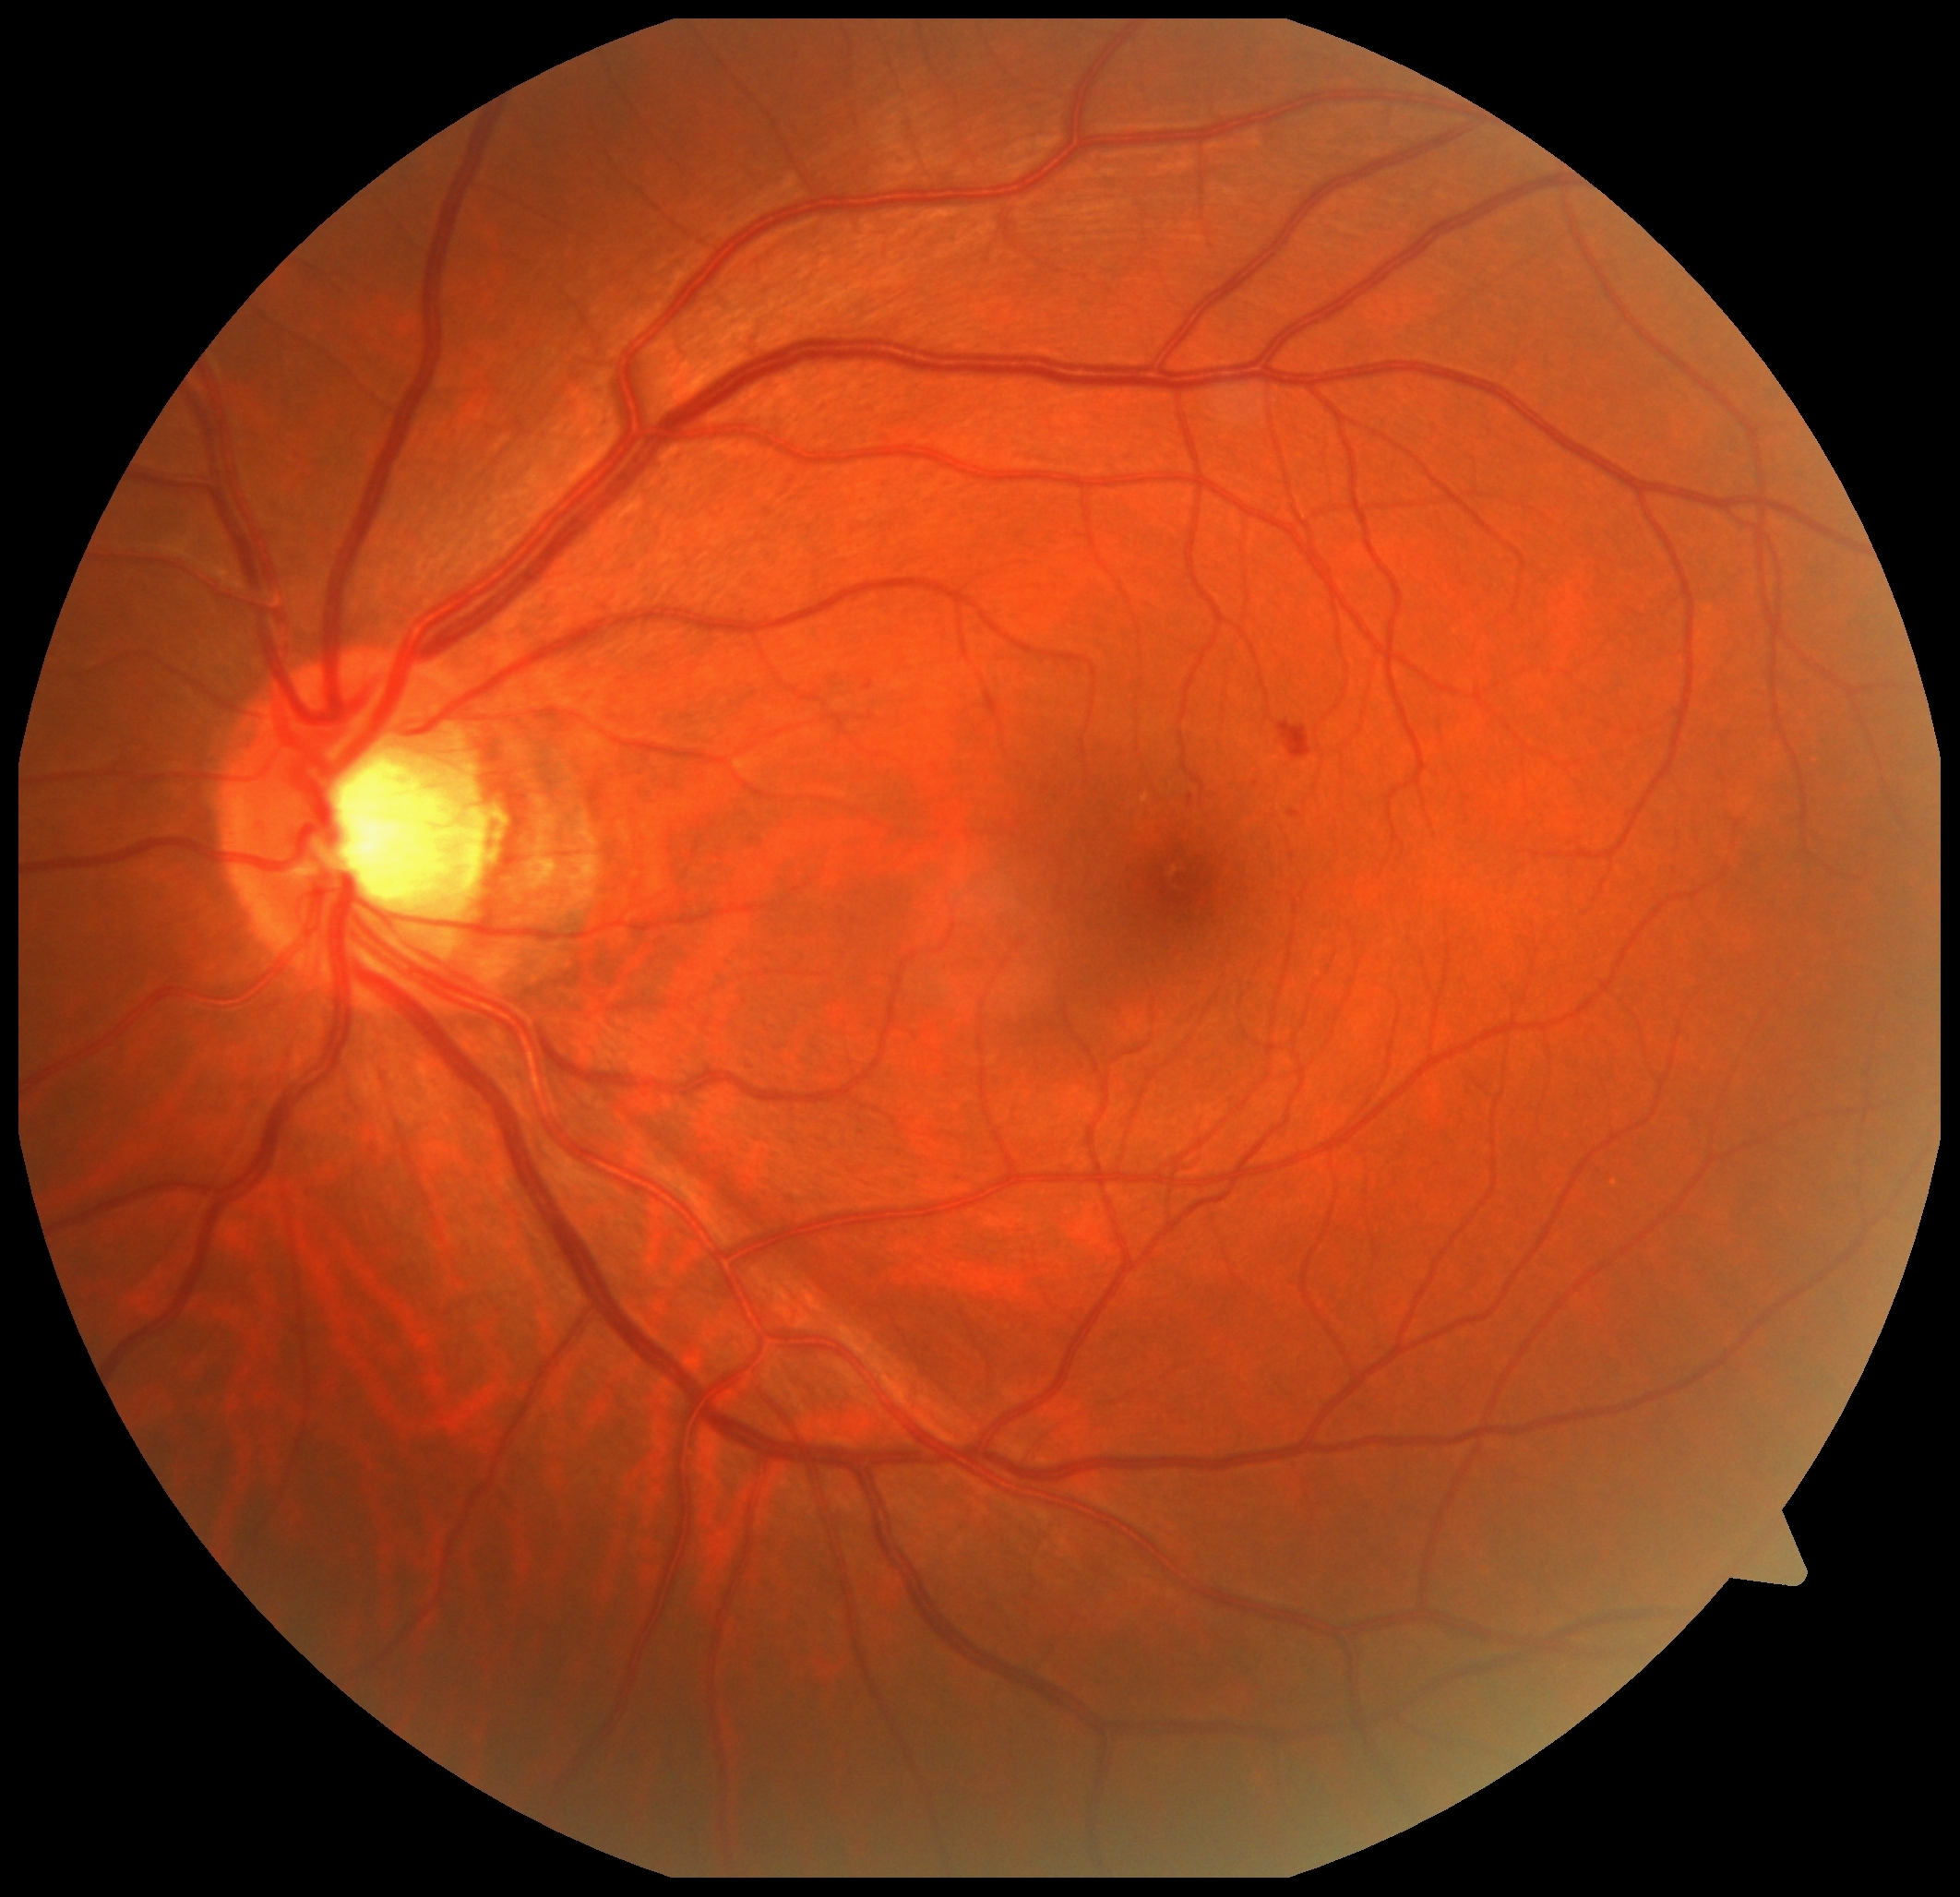 Disease class: non-proliferative diabetic retinopathy.
Diabetic retinopathy grade: 2/4.